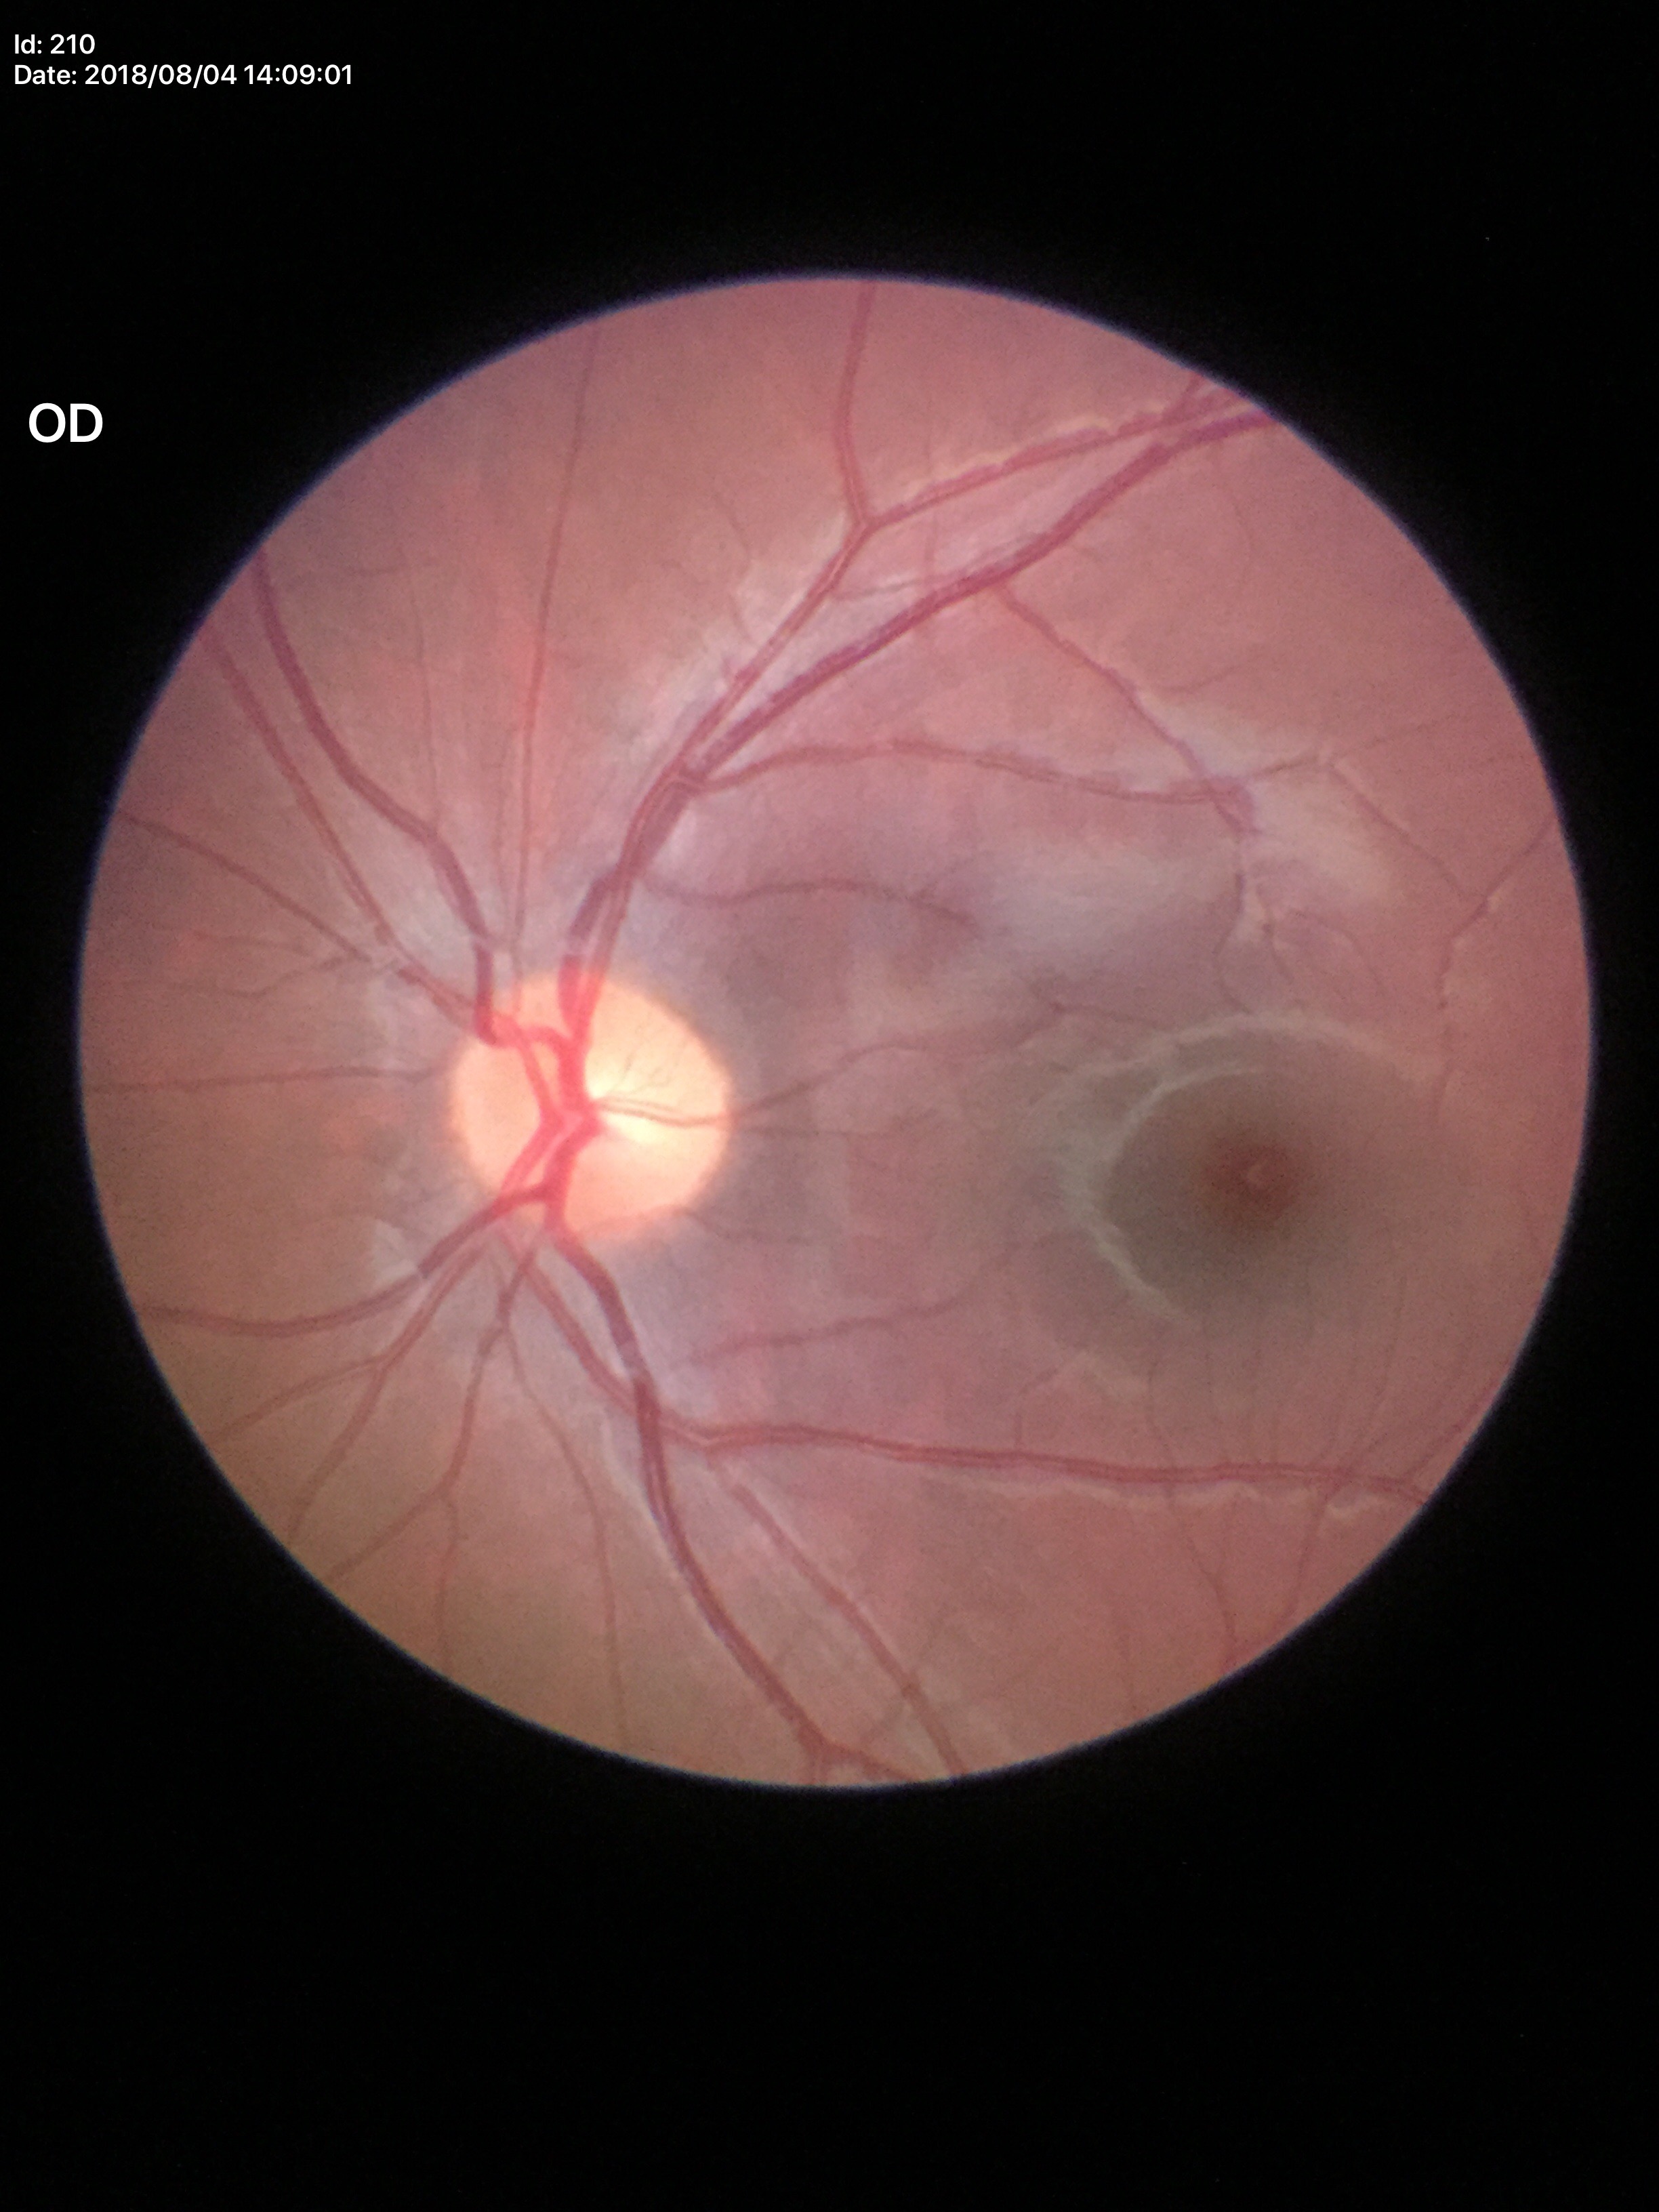 Glaucoma impression = not suspect, VCDR = 0.45, HCDR = 0.50.